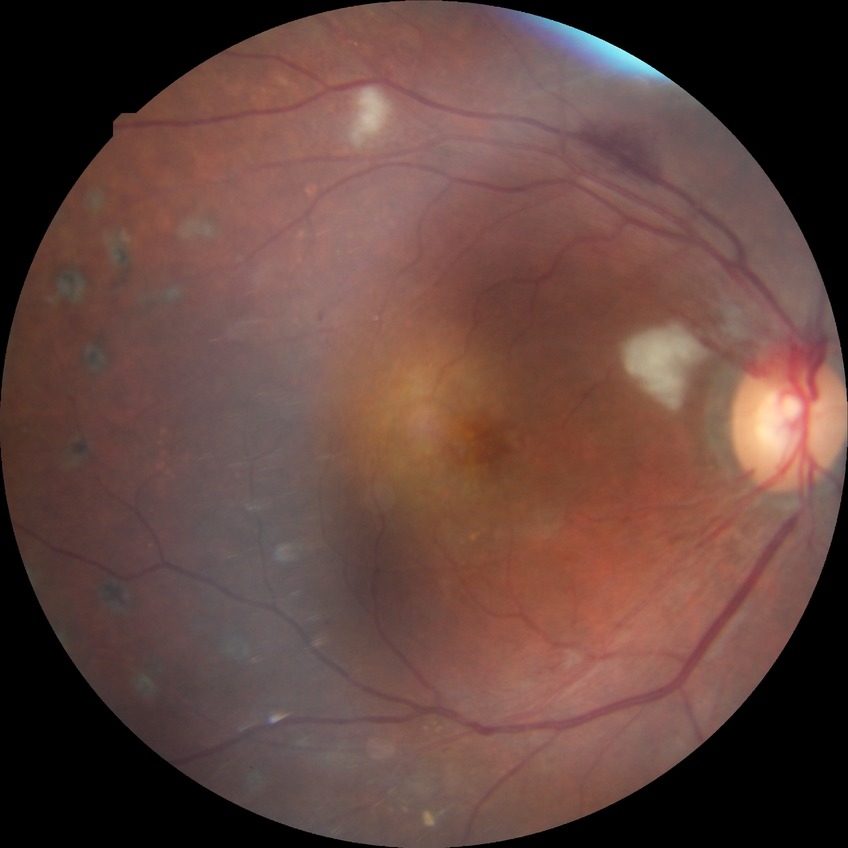

Modified Davis grading is proliferative diabetic retinopathy.